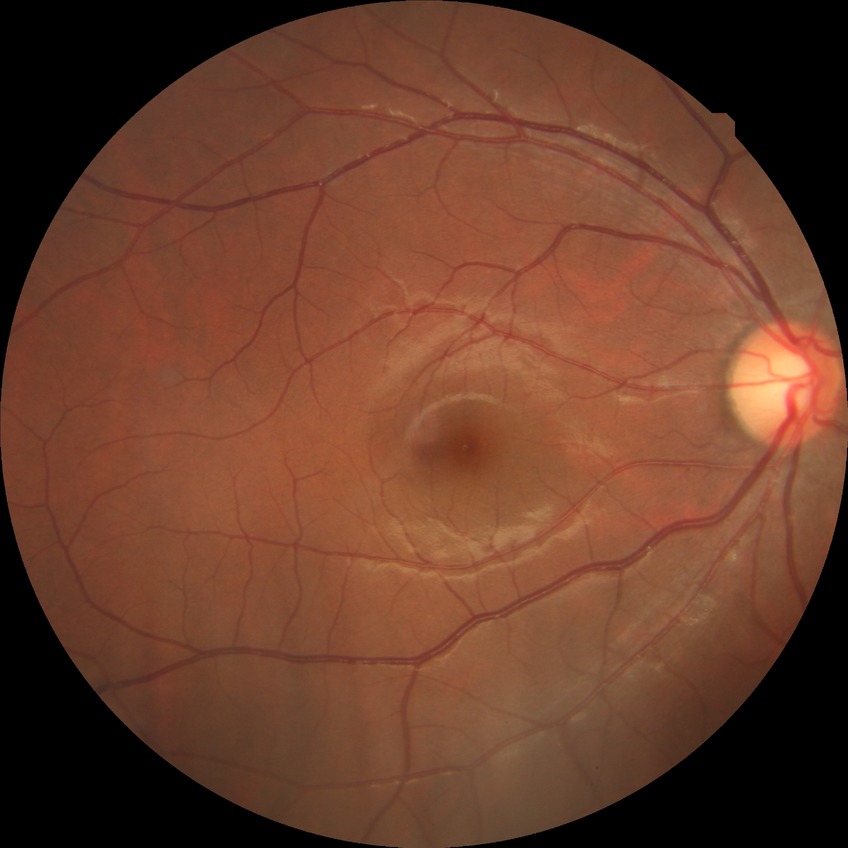
Davis stage: NDR.